Image size 848x848.
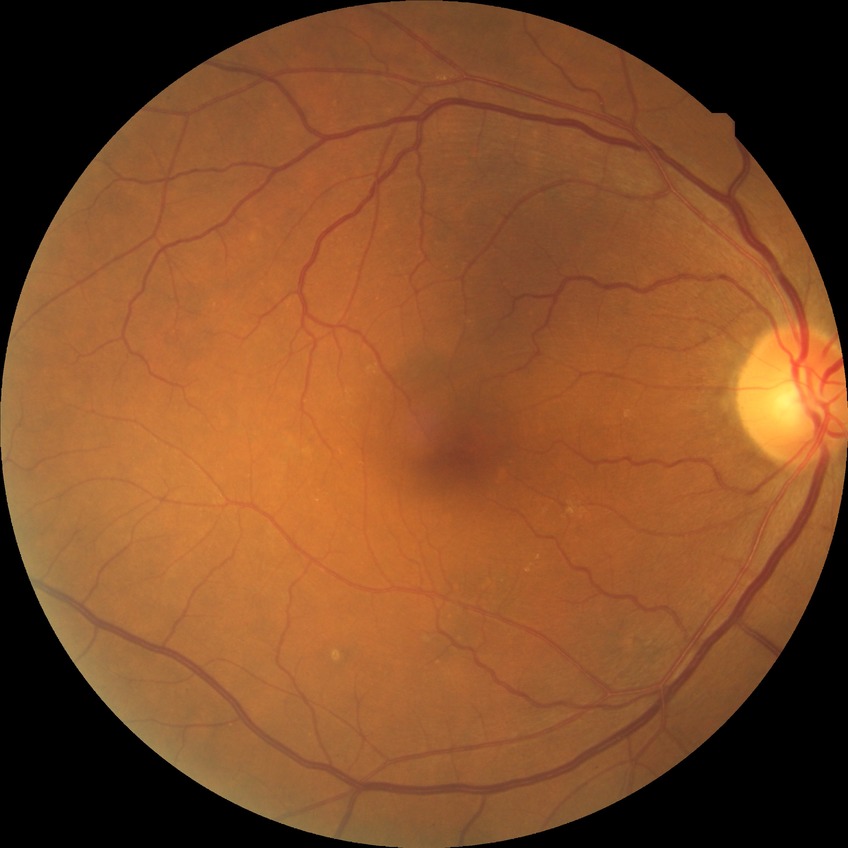
diabetic retinopathy (DR): no diabetic retinopathy (NDR).